Color fundus photograph
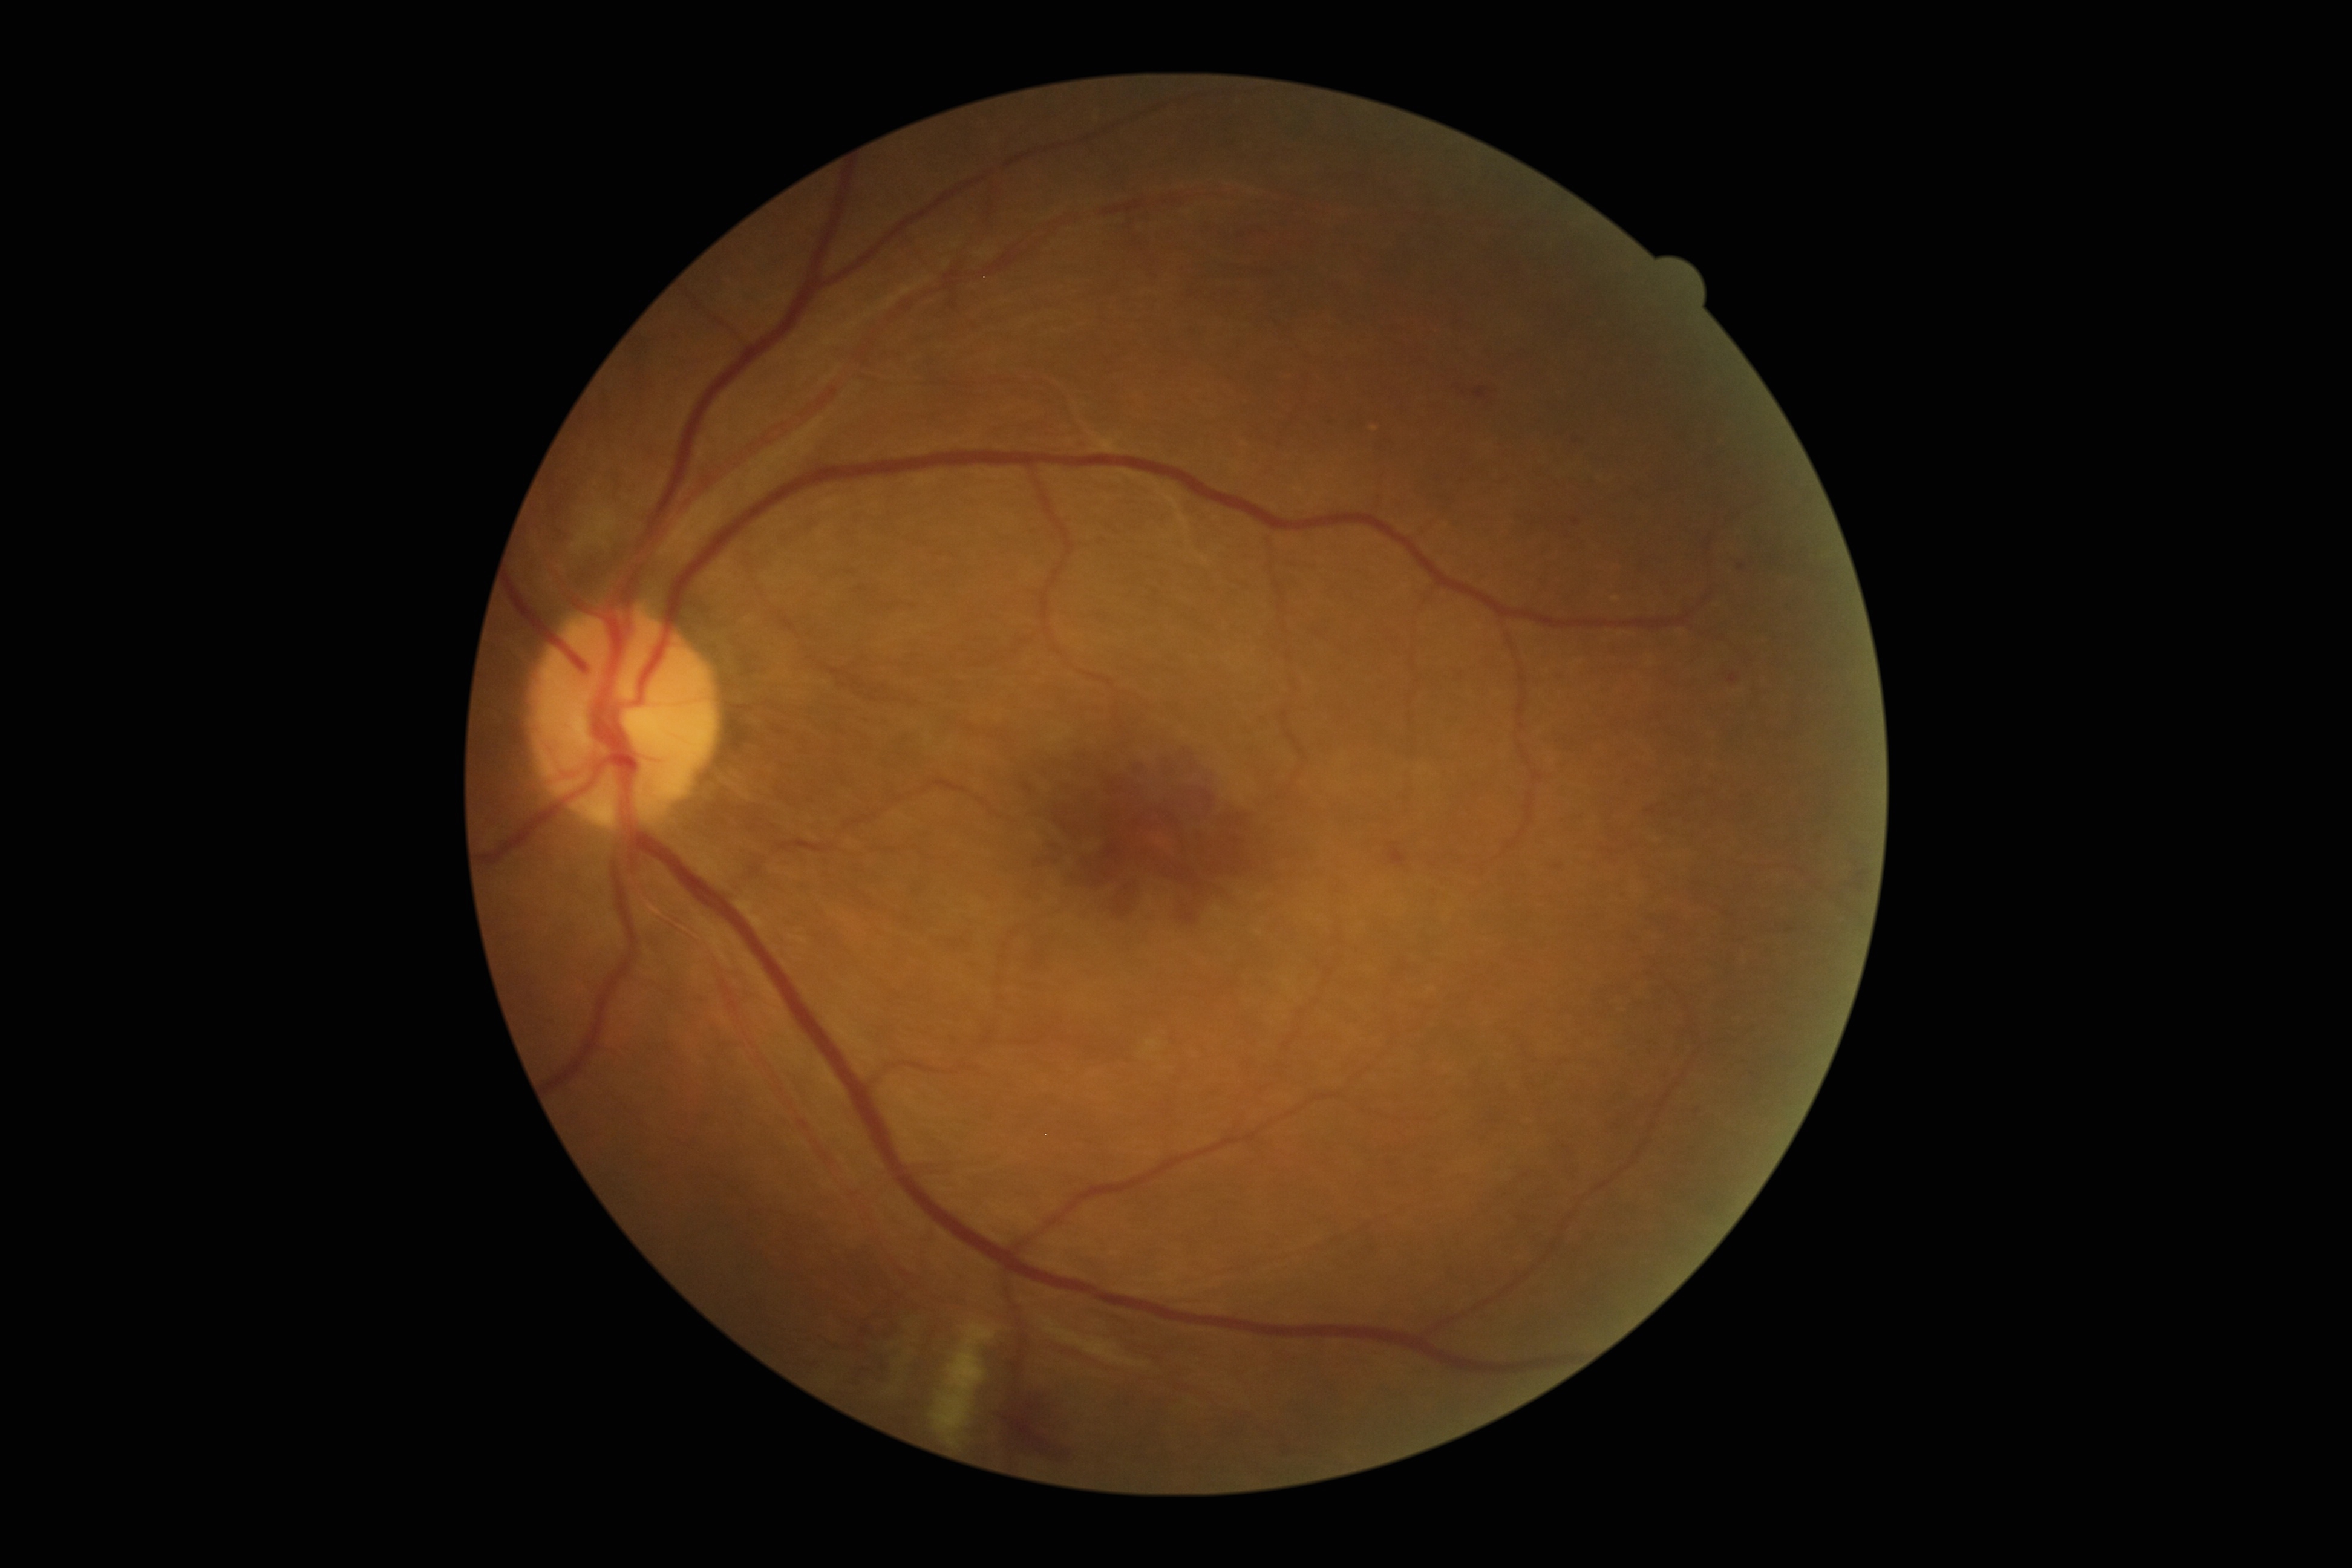

DR severity=grade 2 (moderate NPDR), DR class=non-proliferative diabetic retinopathy.